45° FOV
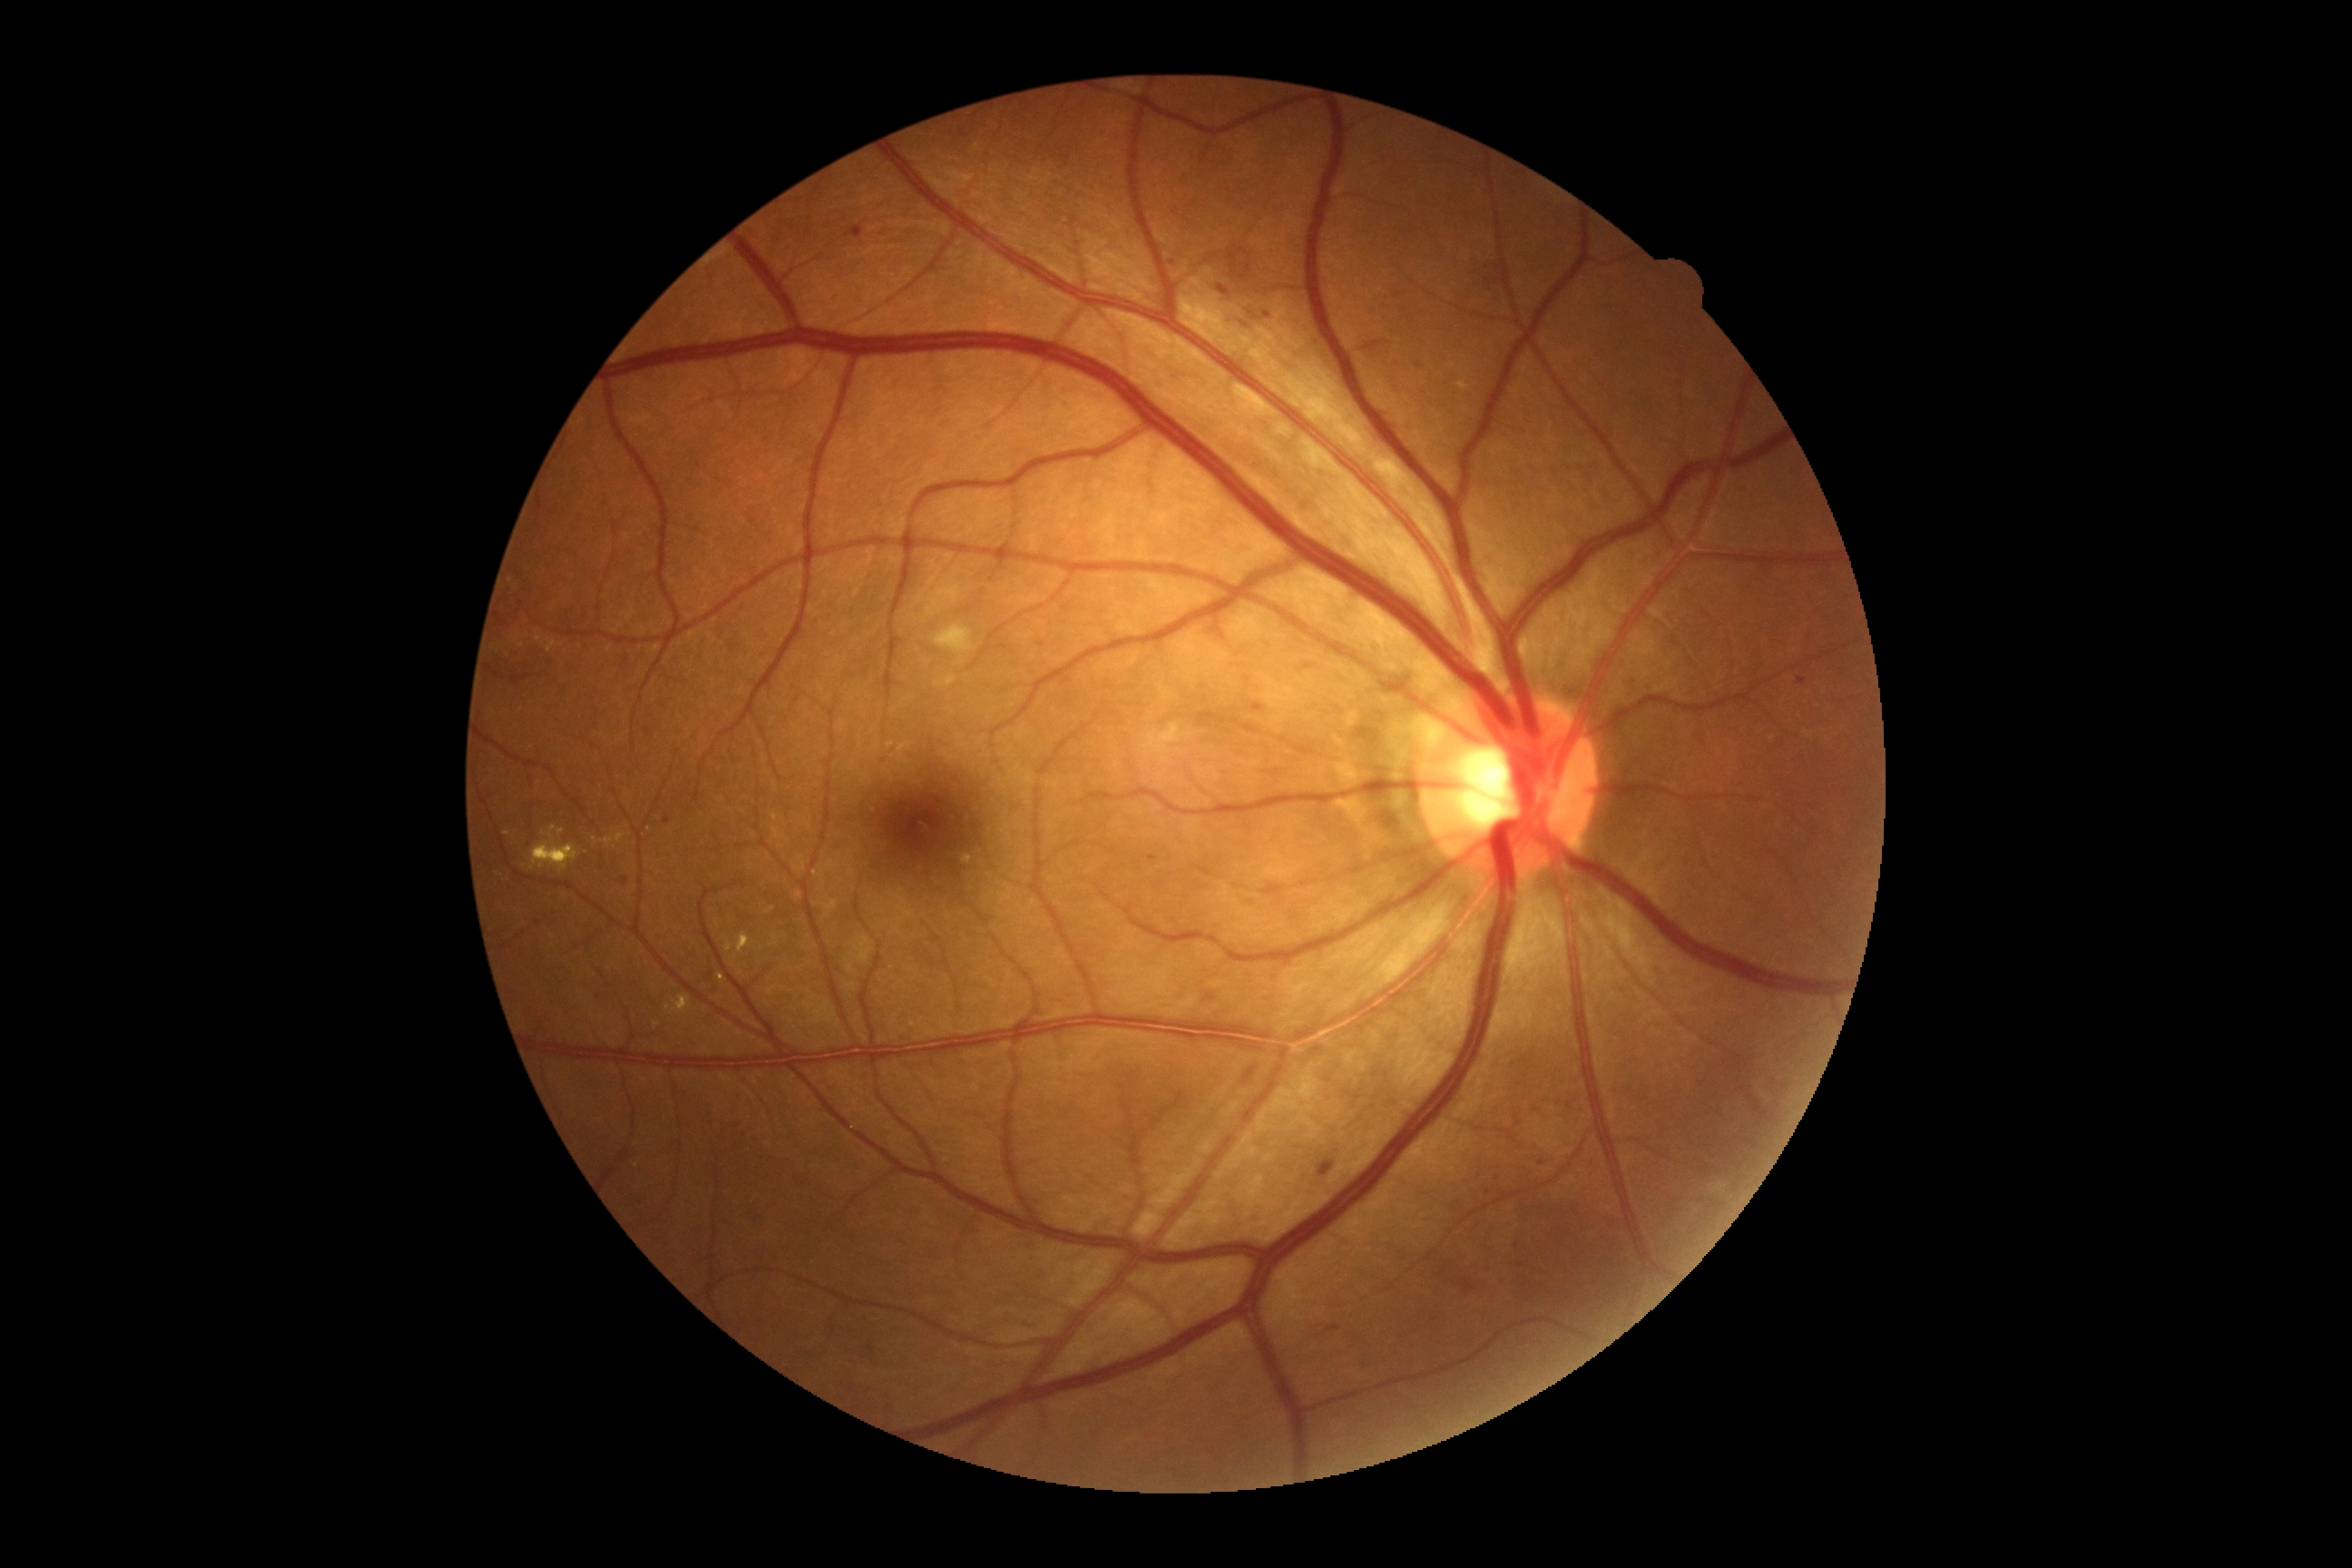

DR class = non-proliferative diabetic retinopathy, diabetic retinopathy (DR) = moderate non-proliferative diabetic retinopathy (grade 2).